1932 by 1910 pixels · 45° FOV — 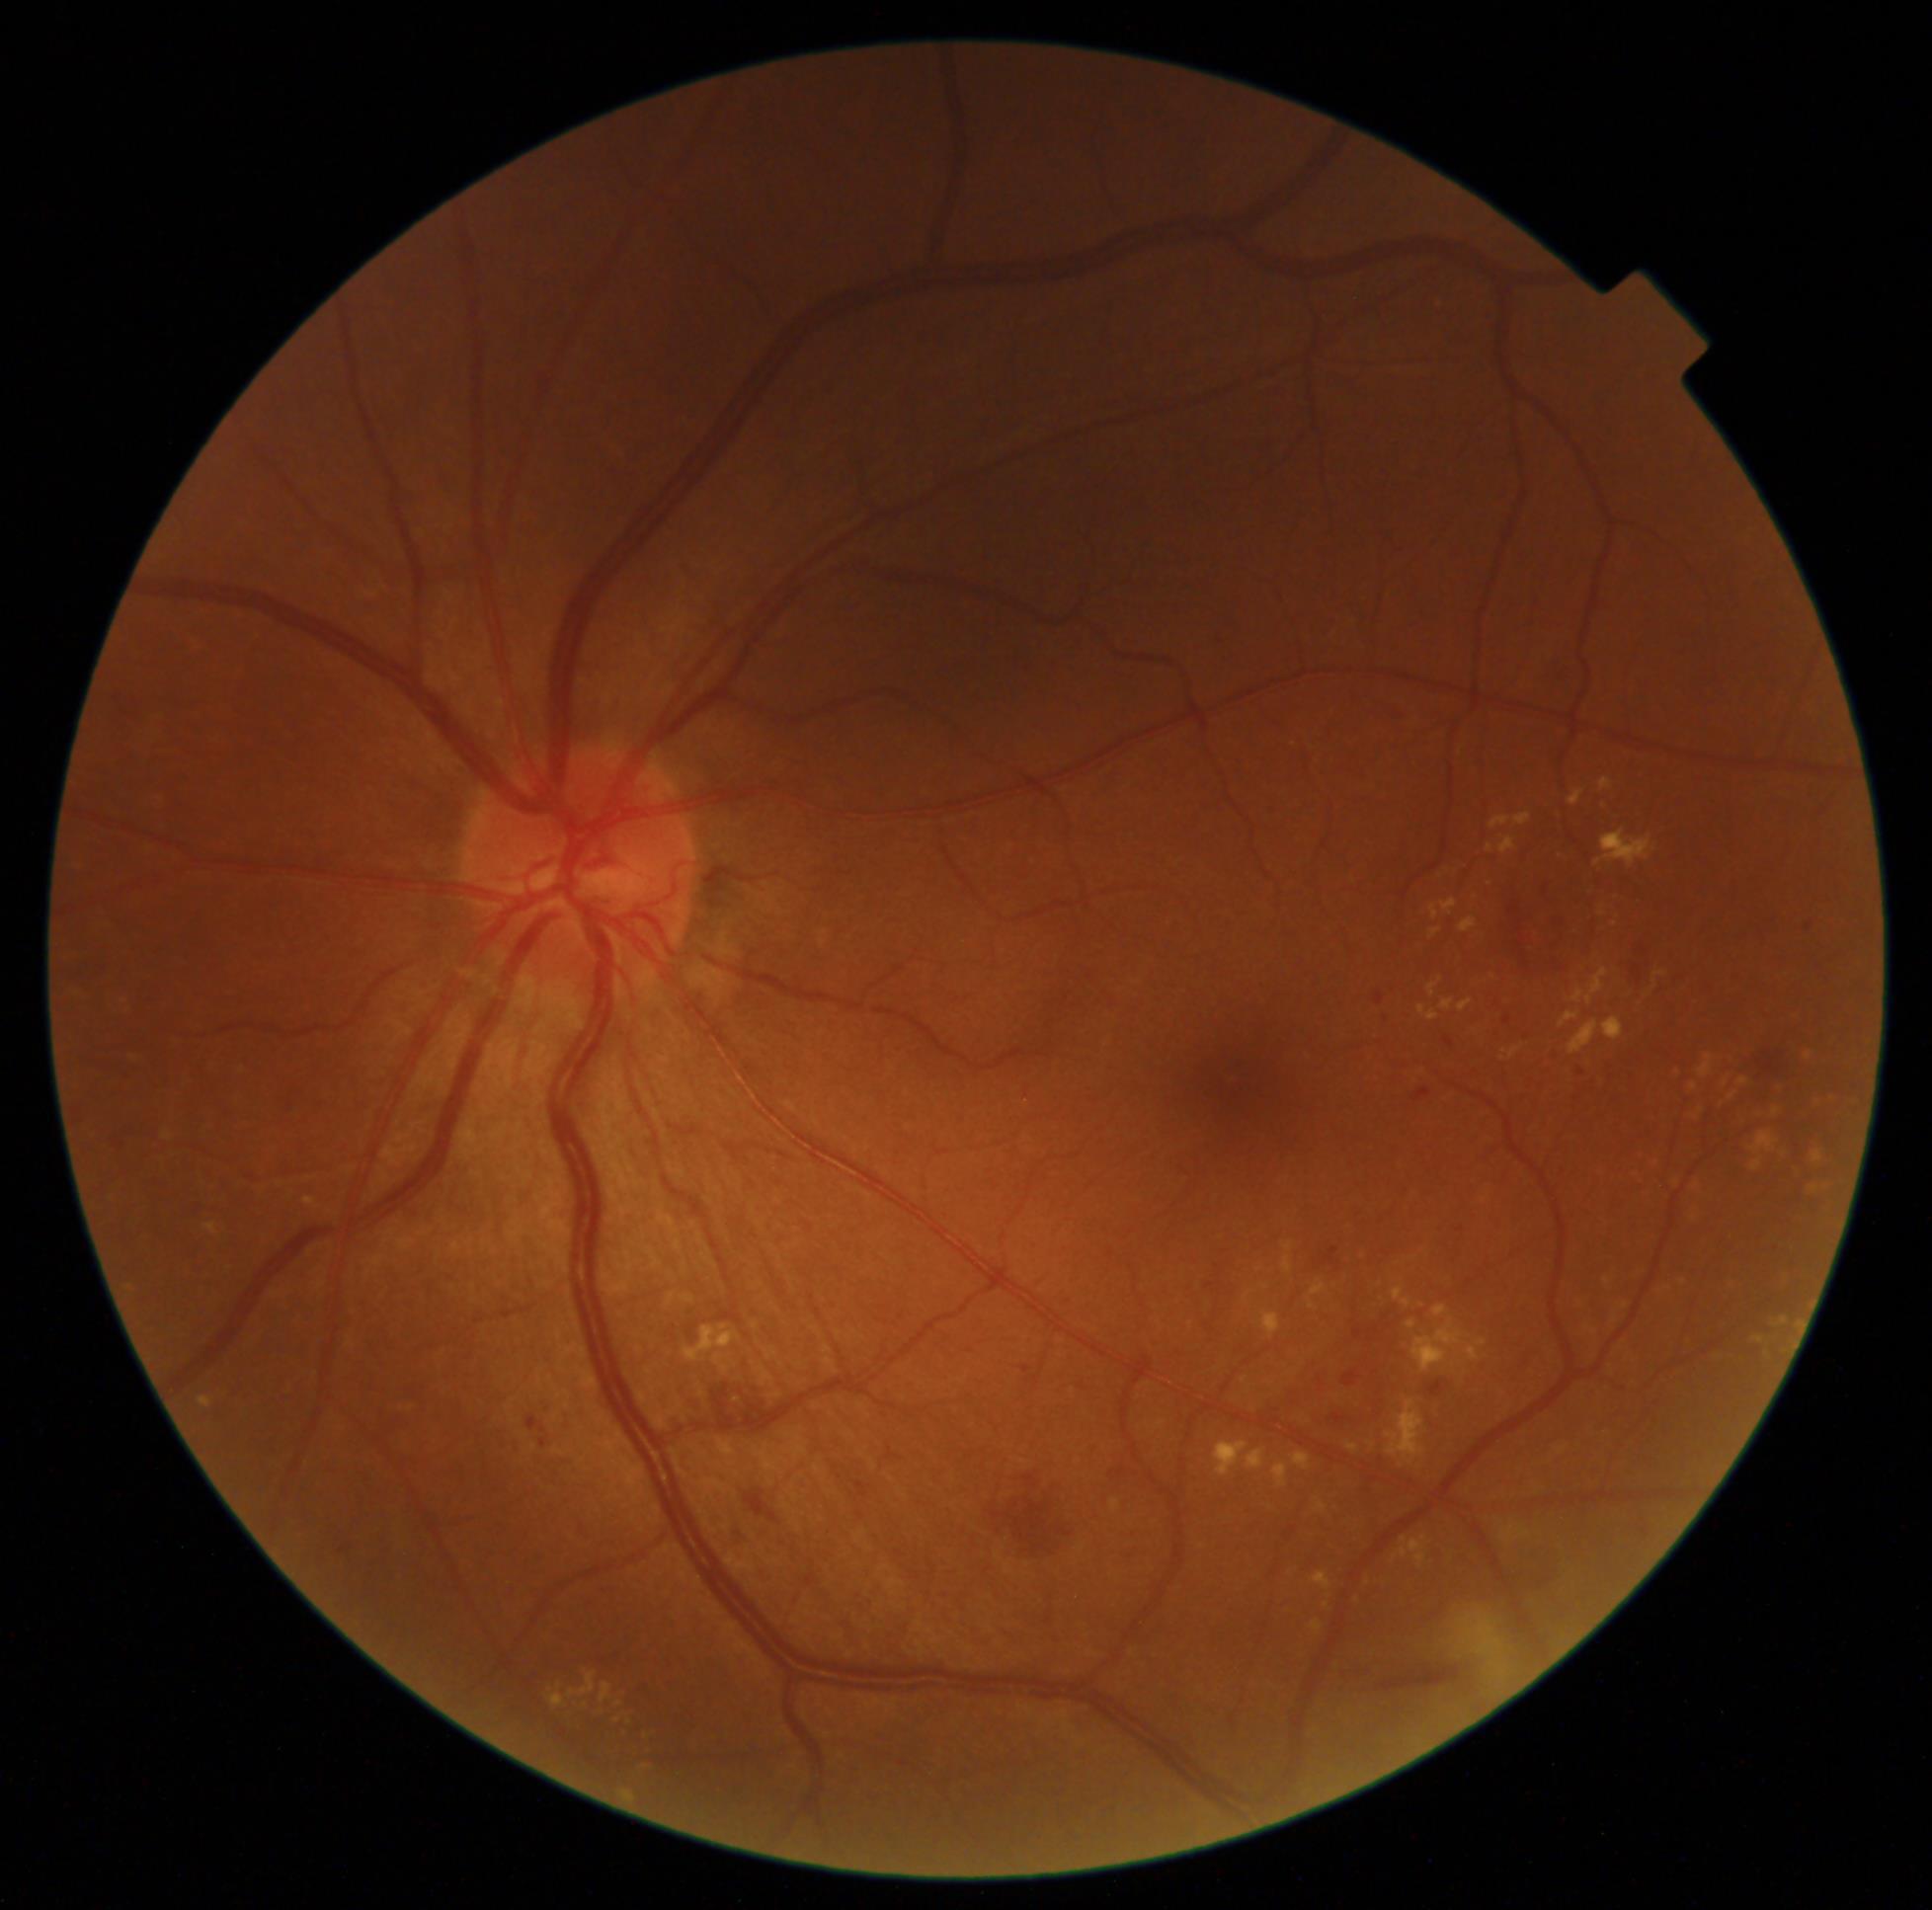

diabetic retinopathy grade = 2 (moderate NPDR).